Image size 768x576. CFP — 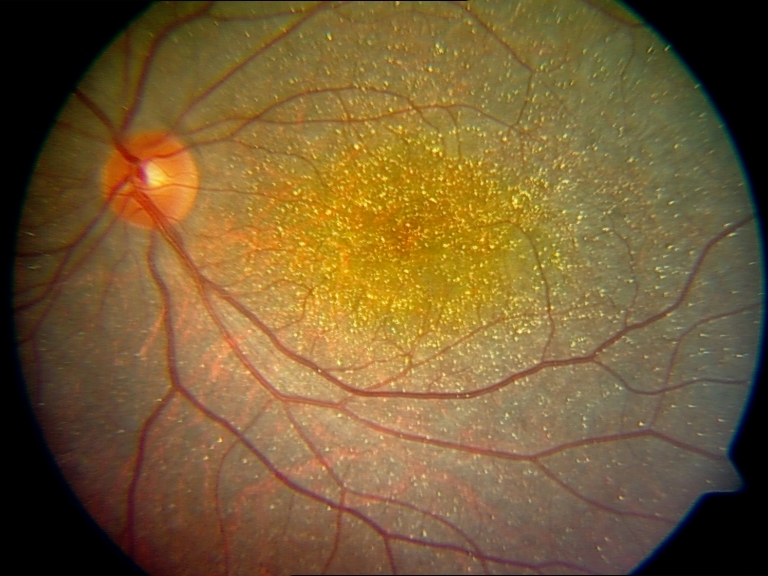 Demonstrates Bietti crystalline dystrophy.